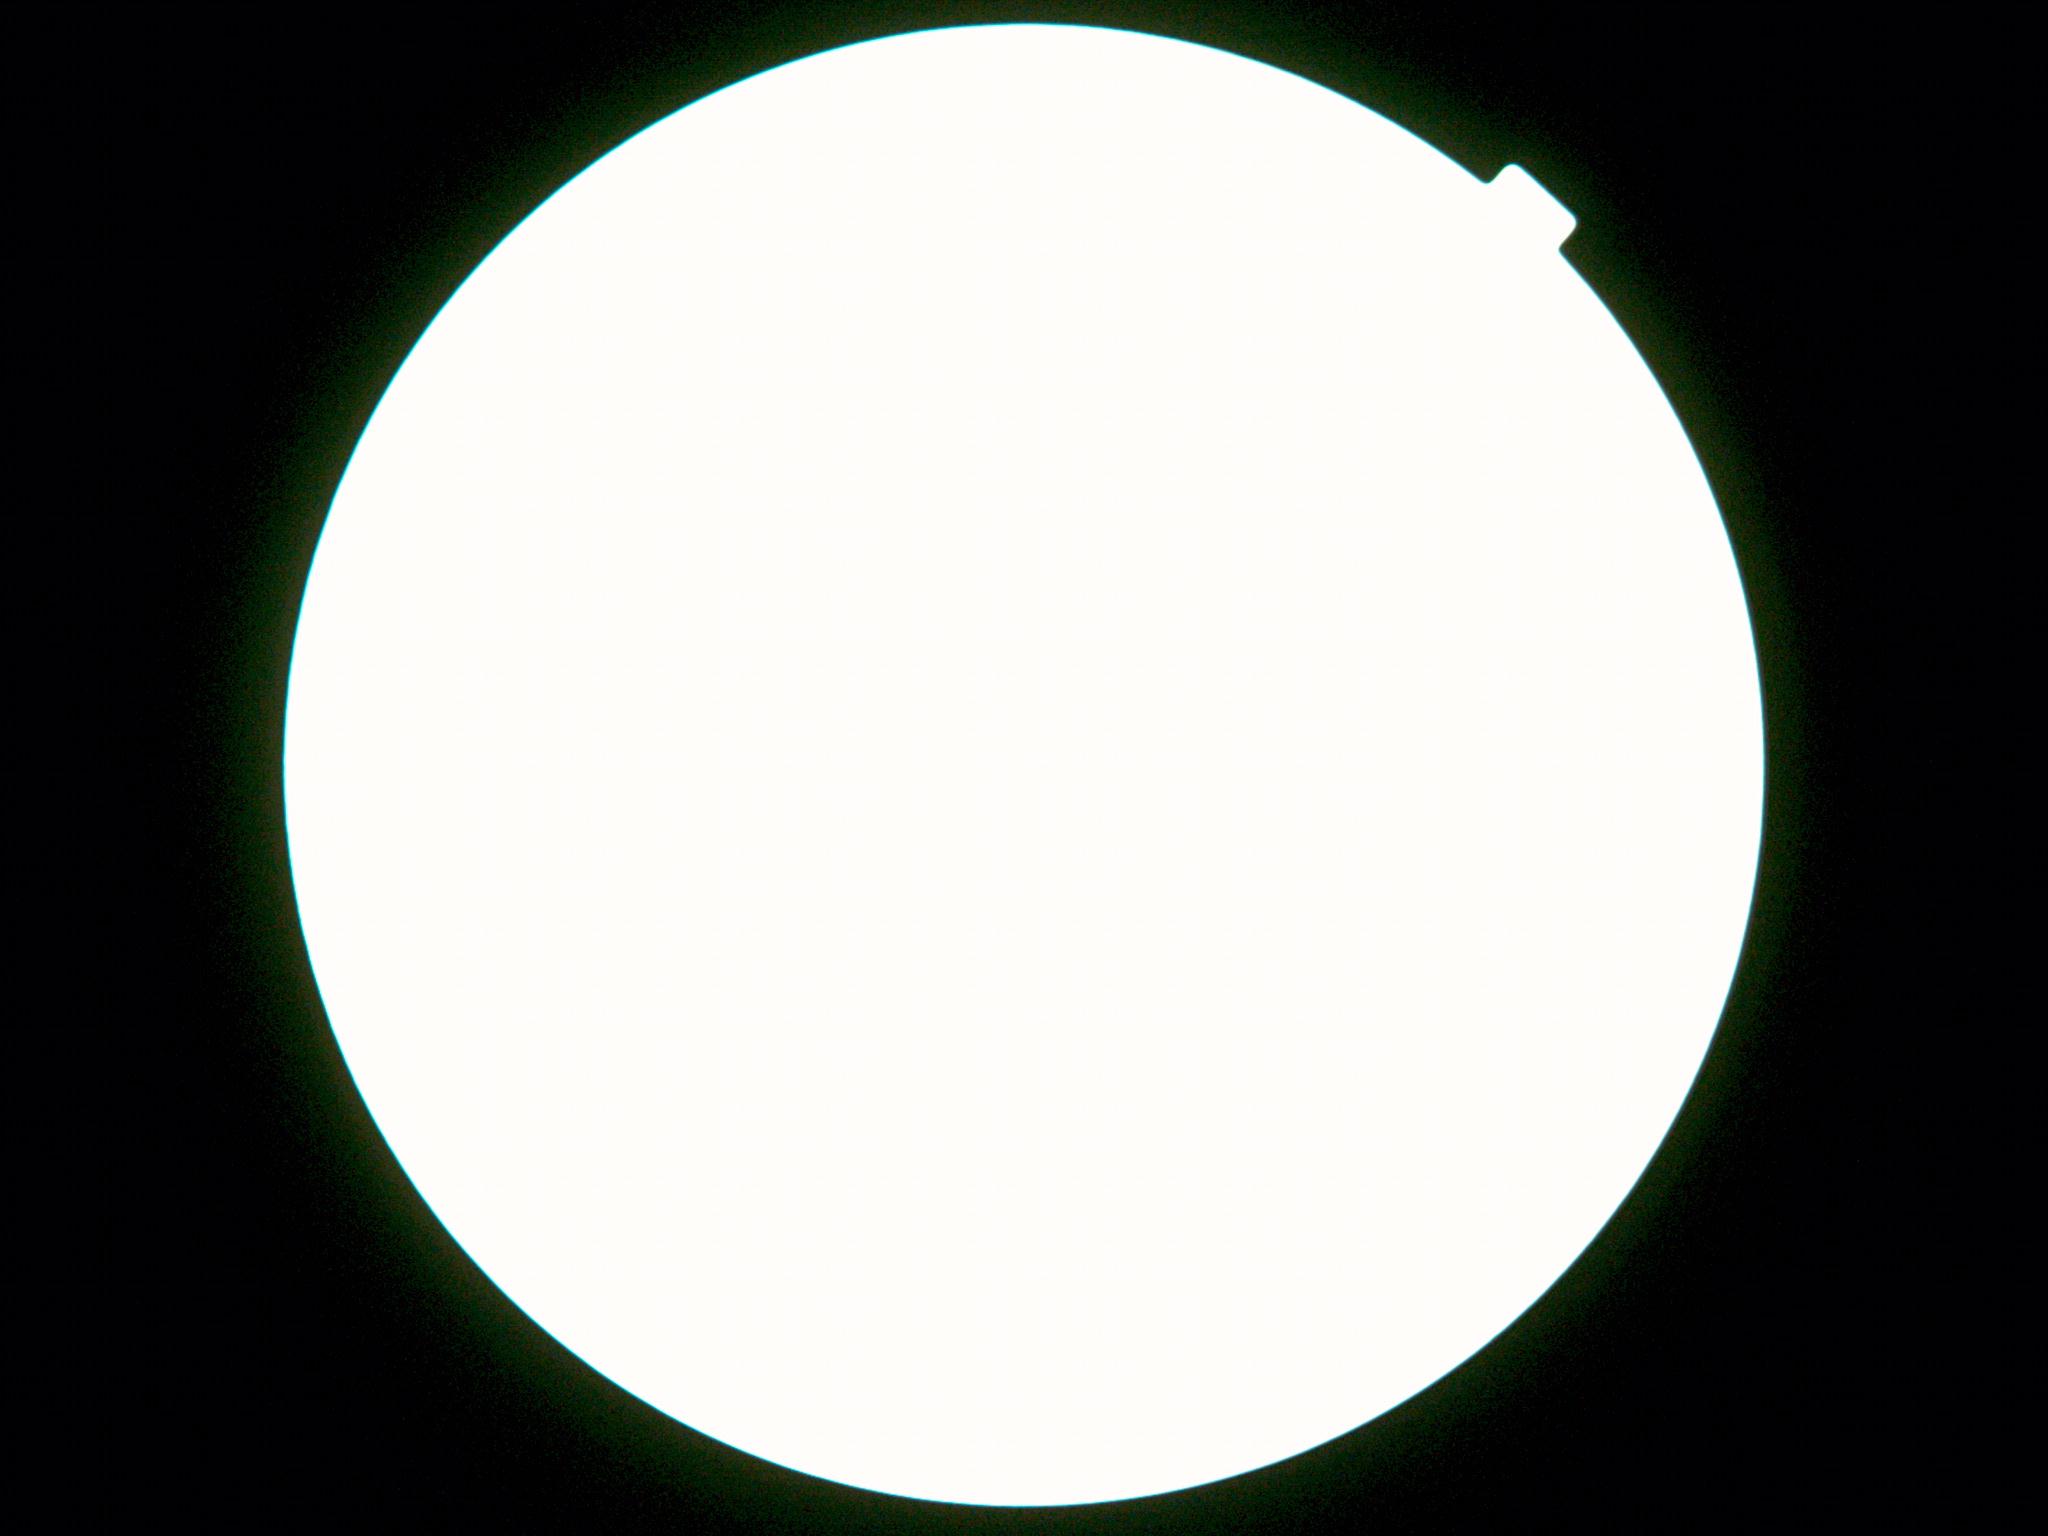

DR severity@ungradable.